Captured on a Topcon TRC-50DX fundus camera, field includes the optic disc and macula: 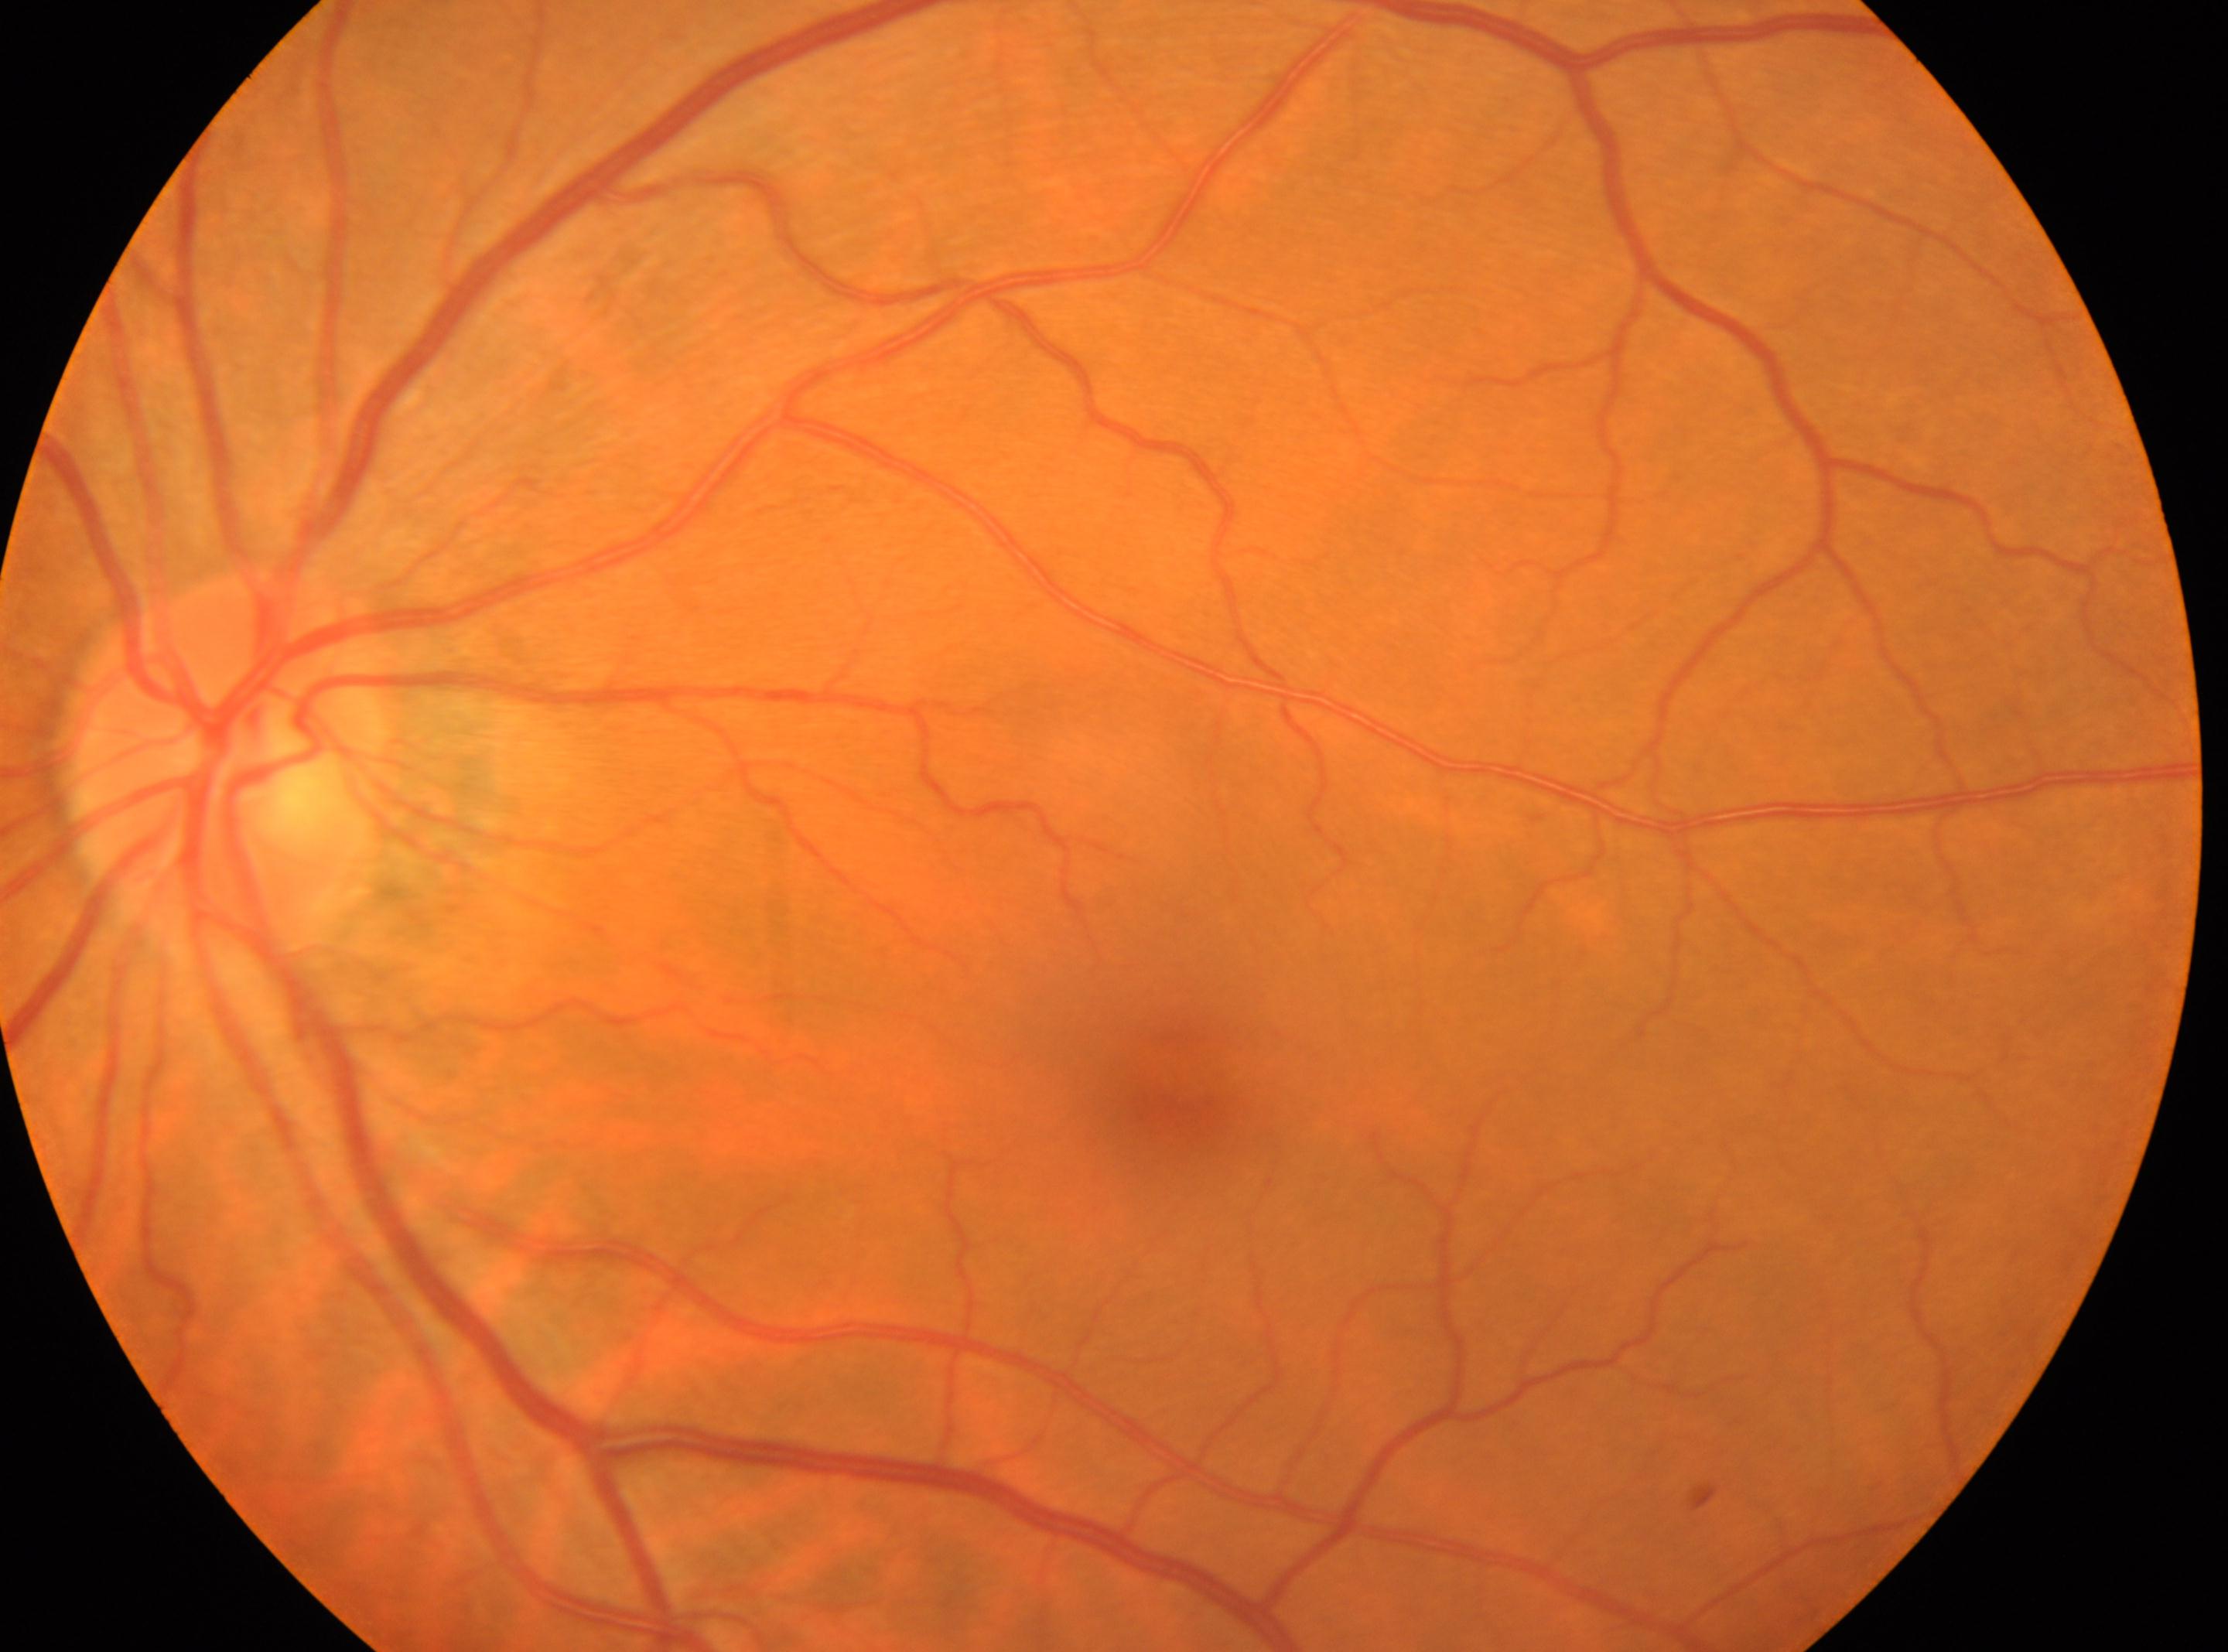
Optic disc center: (x=222, y=773). DR is no apparent retinopathy (grade 0). Macular center located at (x=1188, y=1100). The image shows the oculus sinister.